45° FOV · color fundus photograph · no pharmacologic dilation:
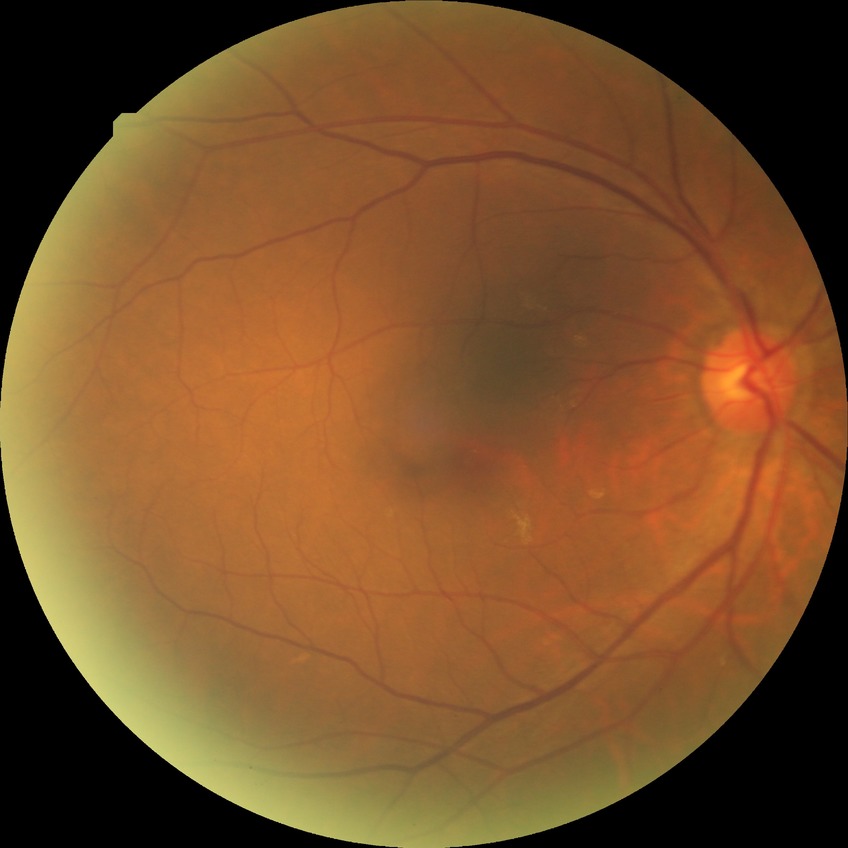 Retinopathy grade: no diabetic retinopathy.